Retinal fundus photograph
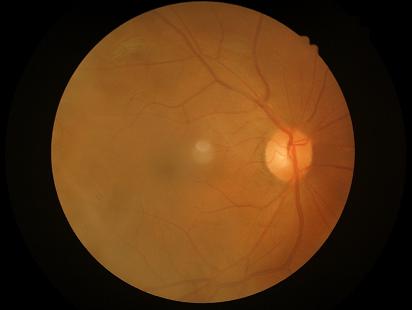   illumination: even and well-balanced
  clarity: noticeable blur in the optic disc, vessels, or background
  contrast: good dynamic range
  overall_quality: poor, ungradable